Wide-field fundus photograph from neonatal ROP screening; 640x480px; 130° field of view (Clarity RetCam 3)
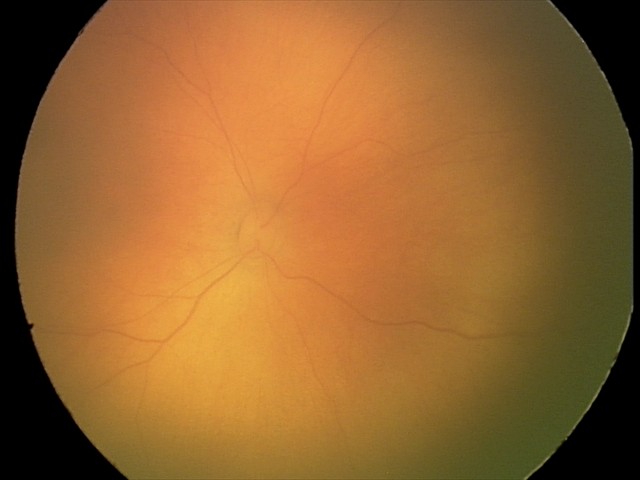

Assessment: no abnormal retinal findings.